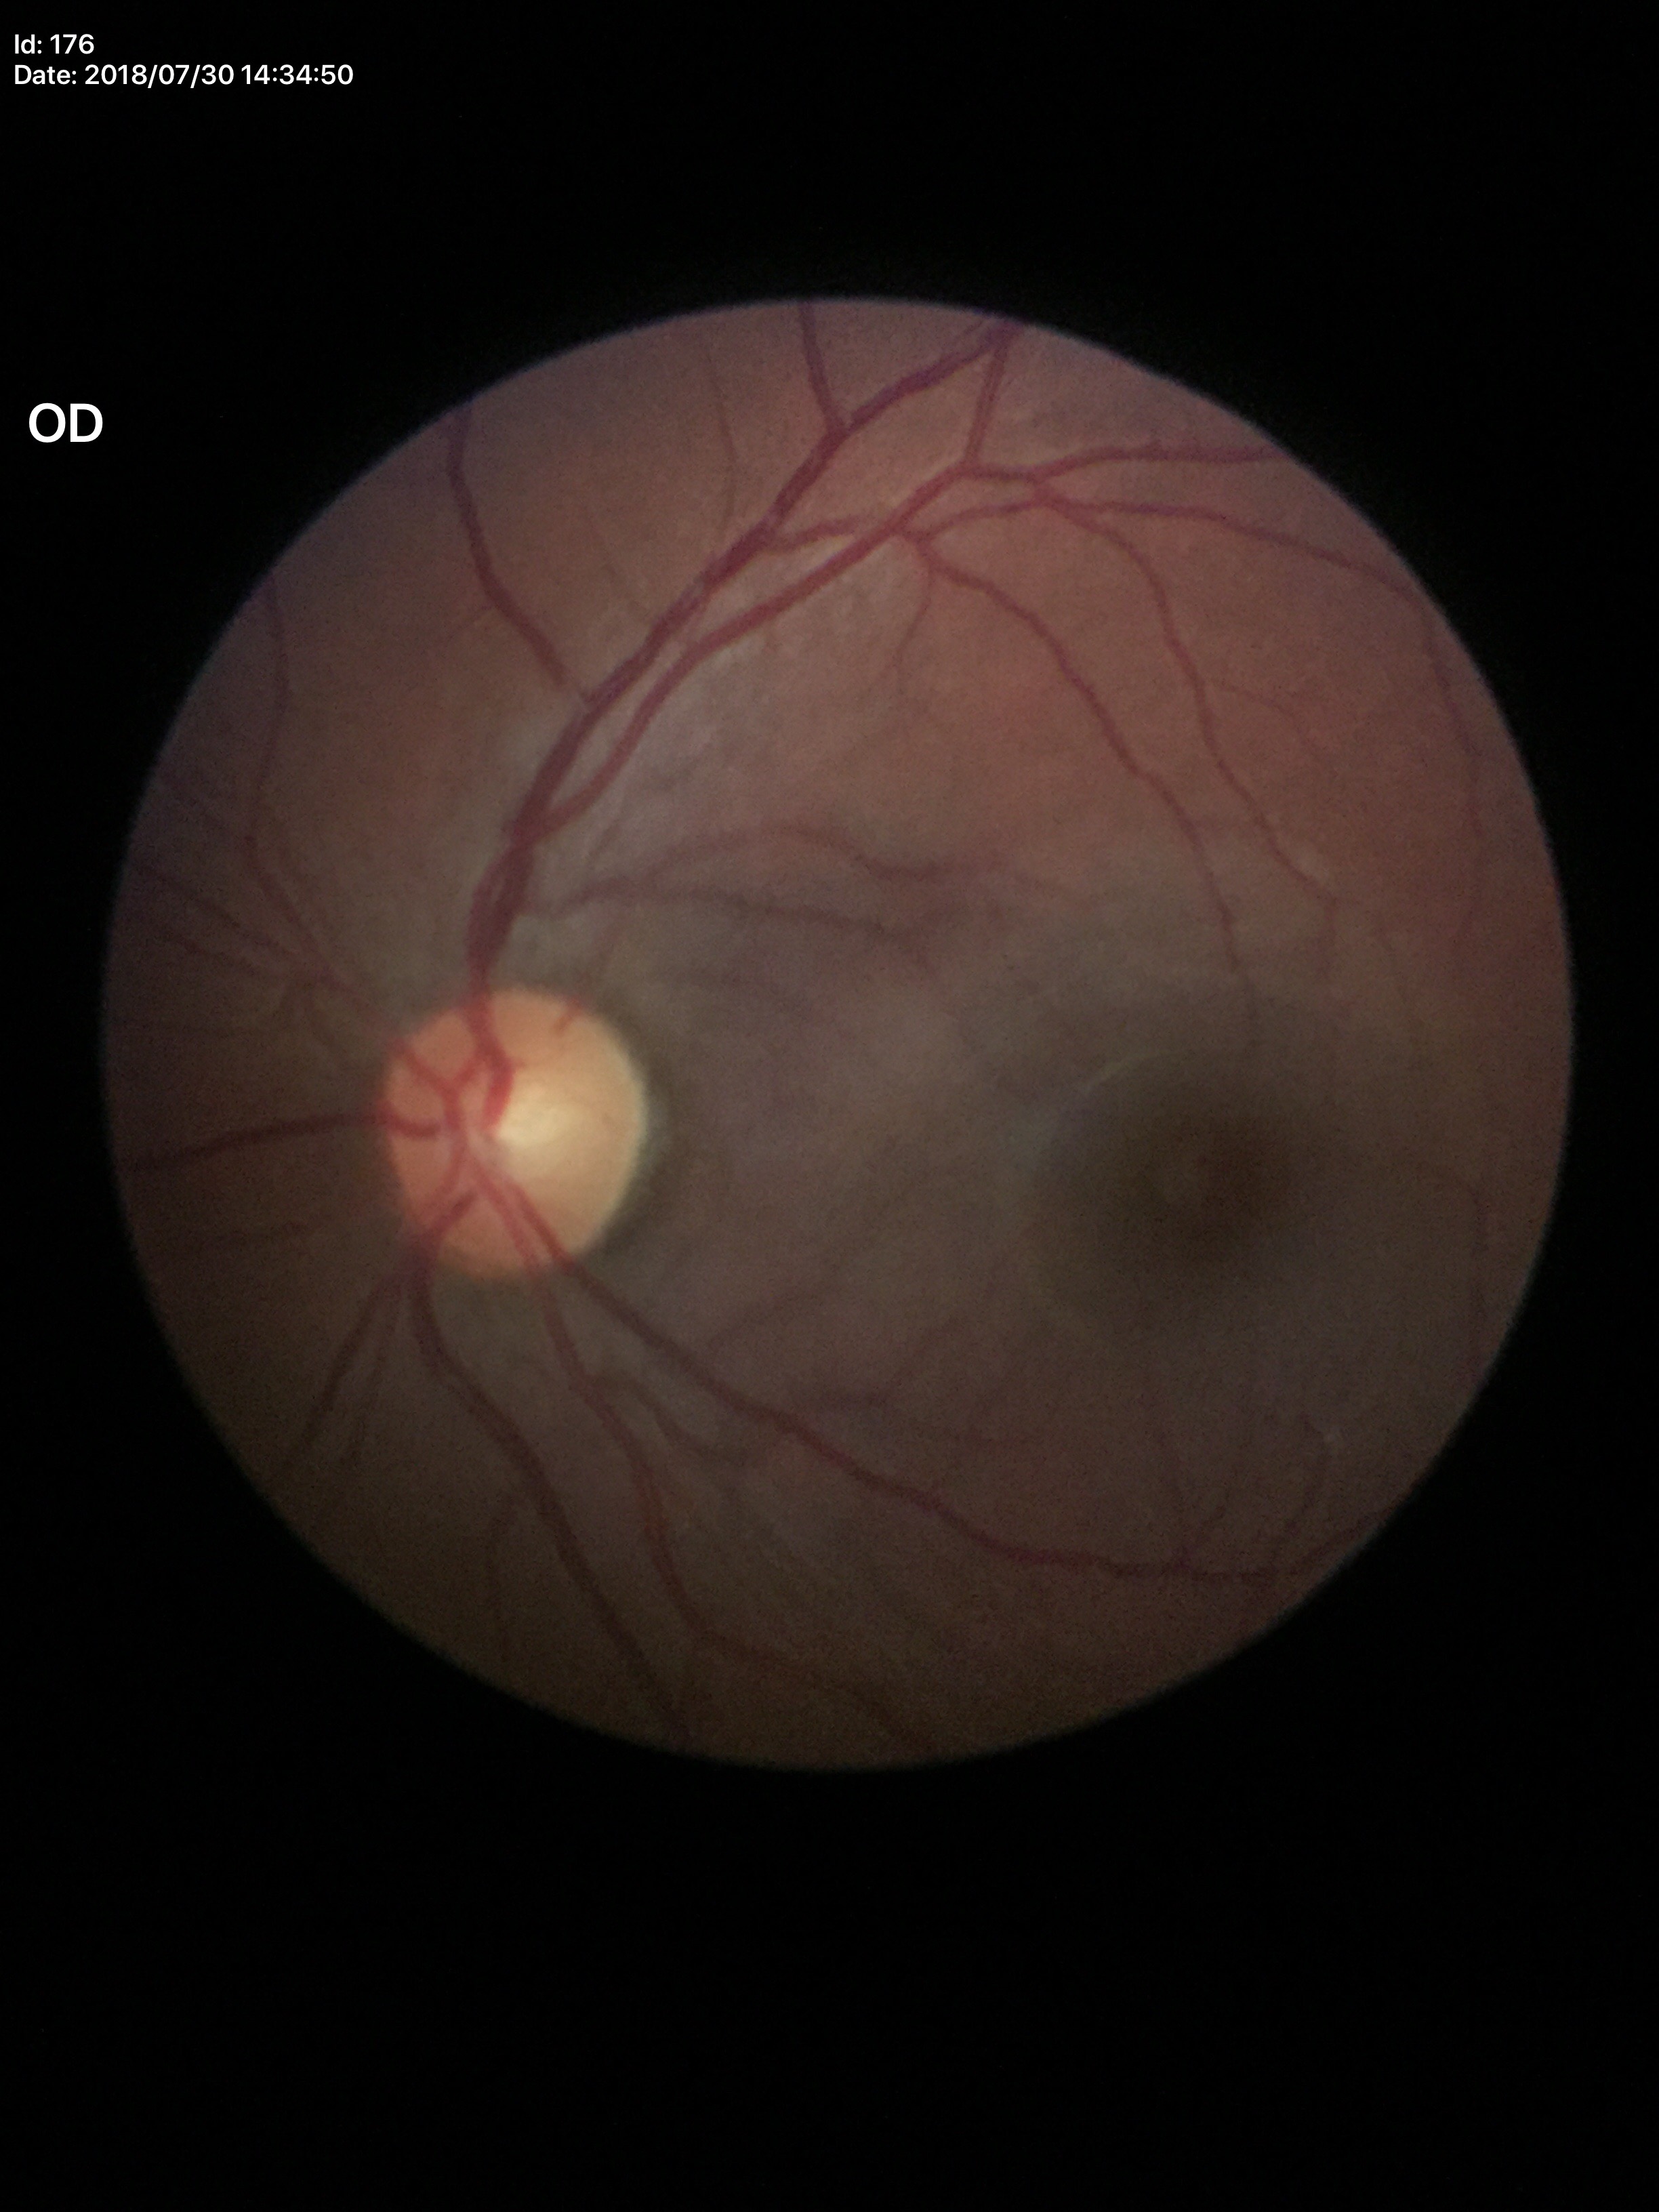

Optic disc analysis:
* Glaucoma evaluation — no suspicious findings
* vertical cup-disc ratio — 0.49
* horizontal CDR — 0.54